848x848px; nonmydriatic.
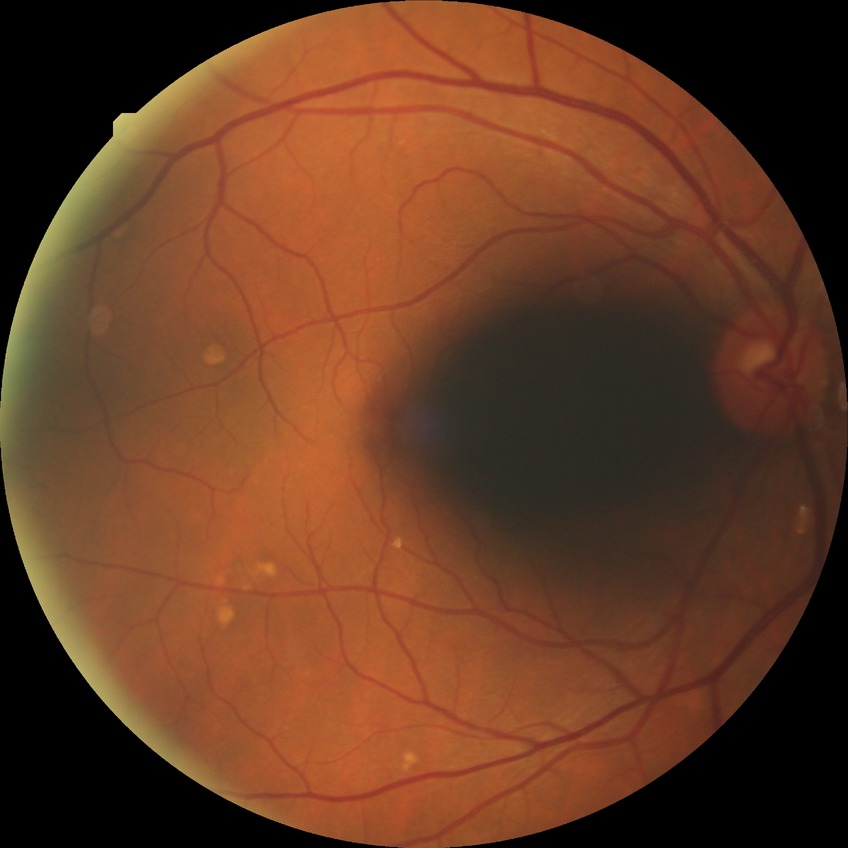
Findings:
– diabetic retinopathy (DR) — no diabetic retinopathy (NDR)